Pupil-dilated; 1932 x 1932 pixels; color fundus photograph:
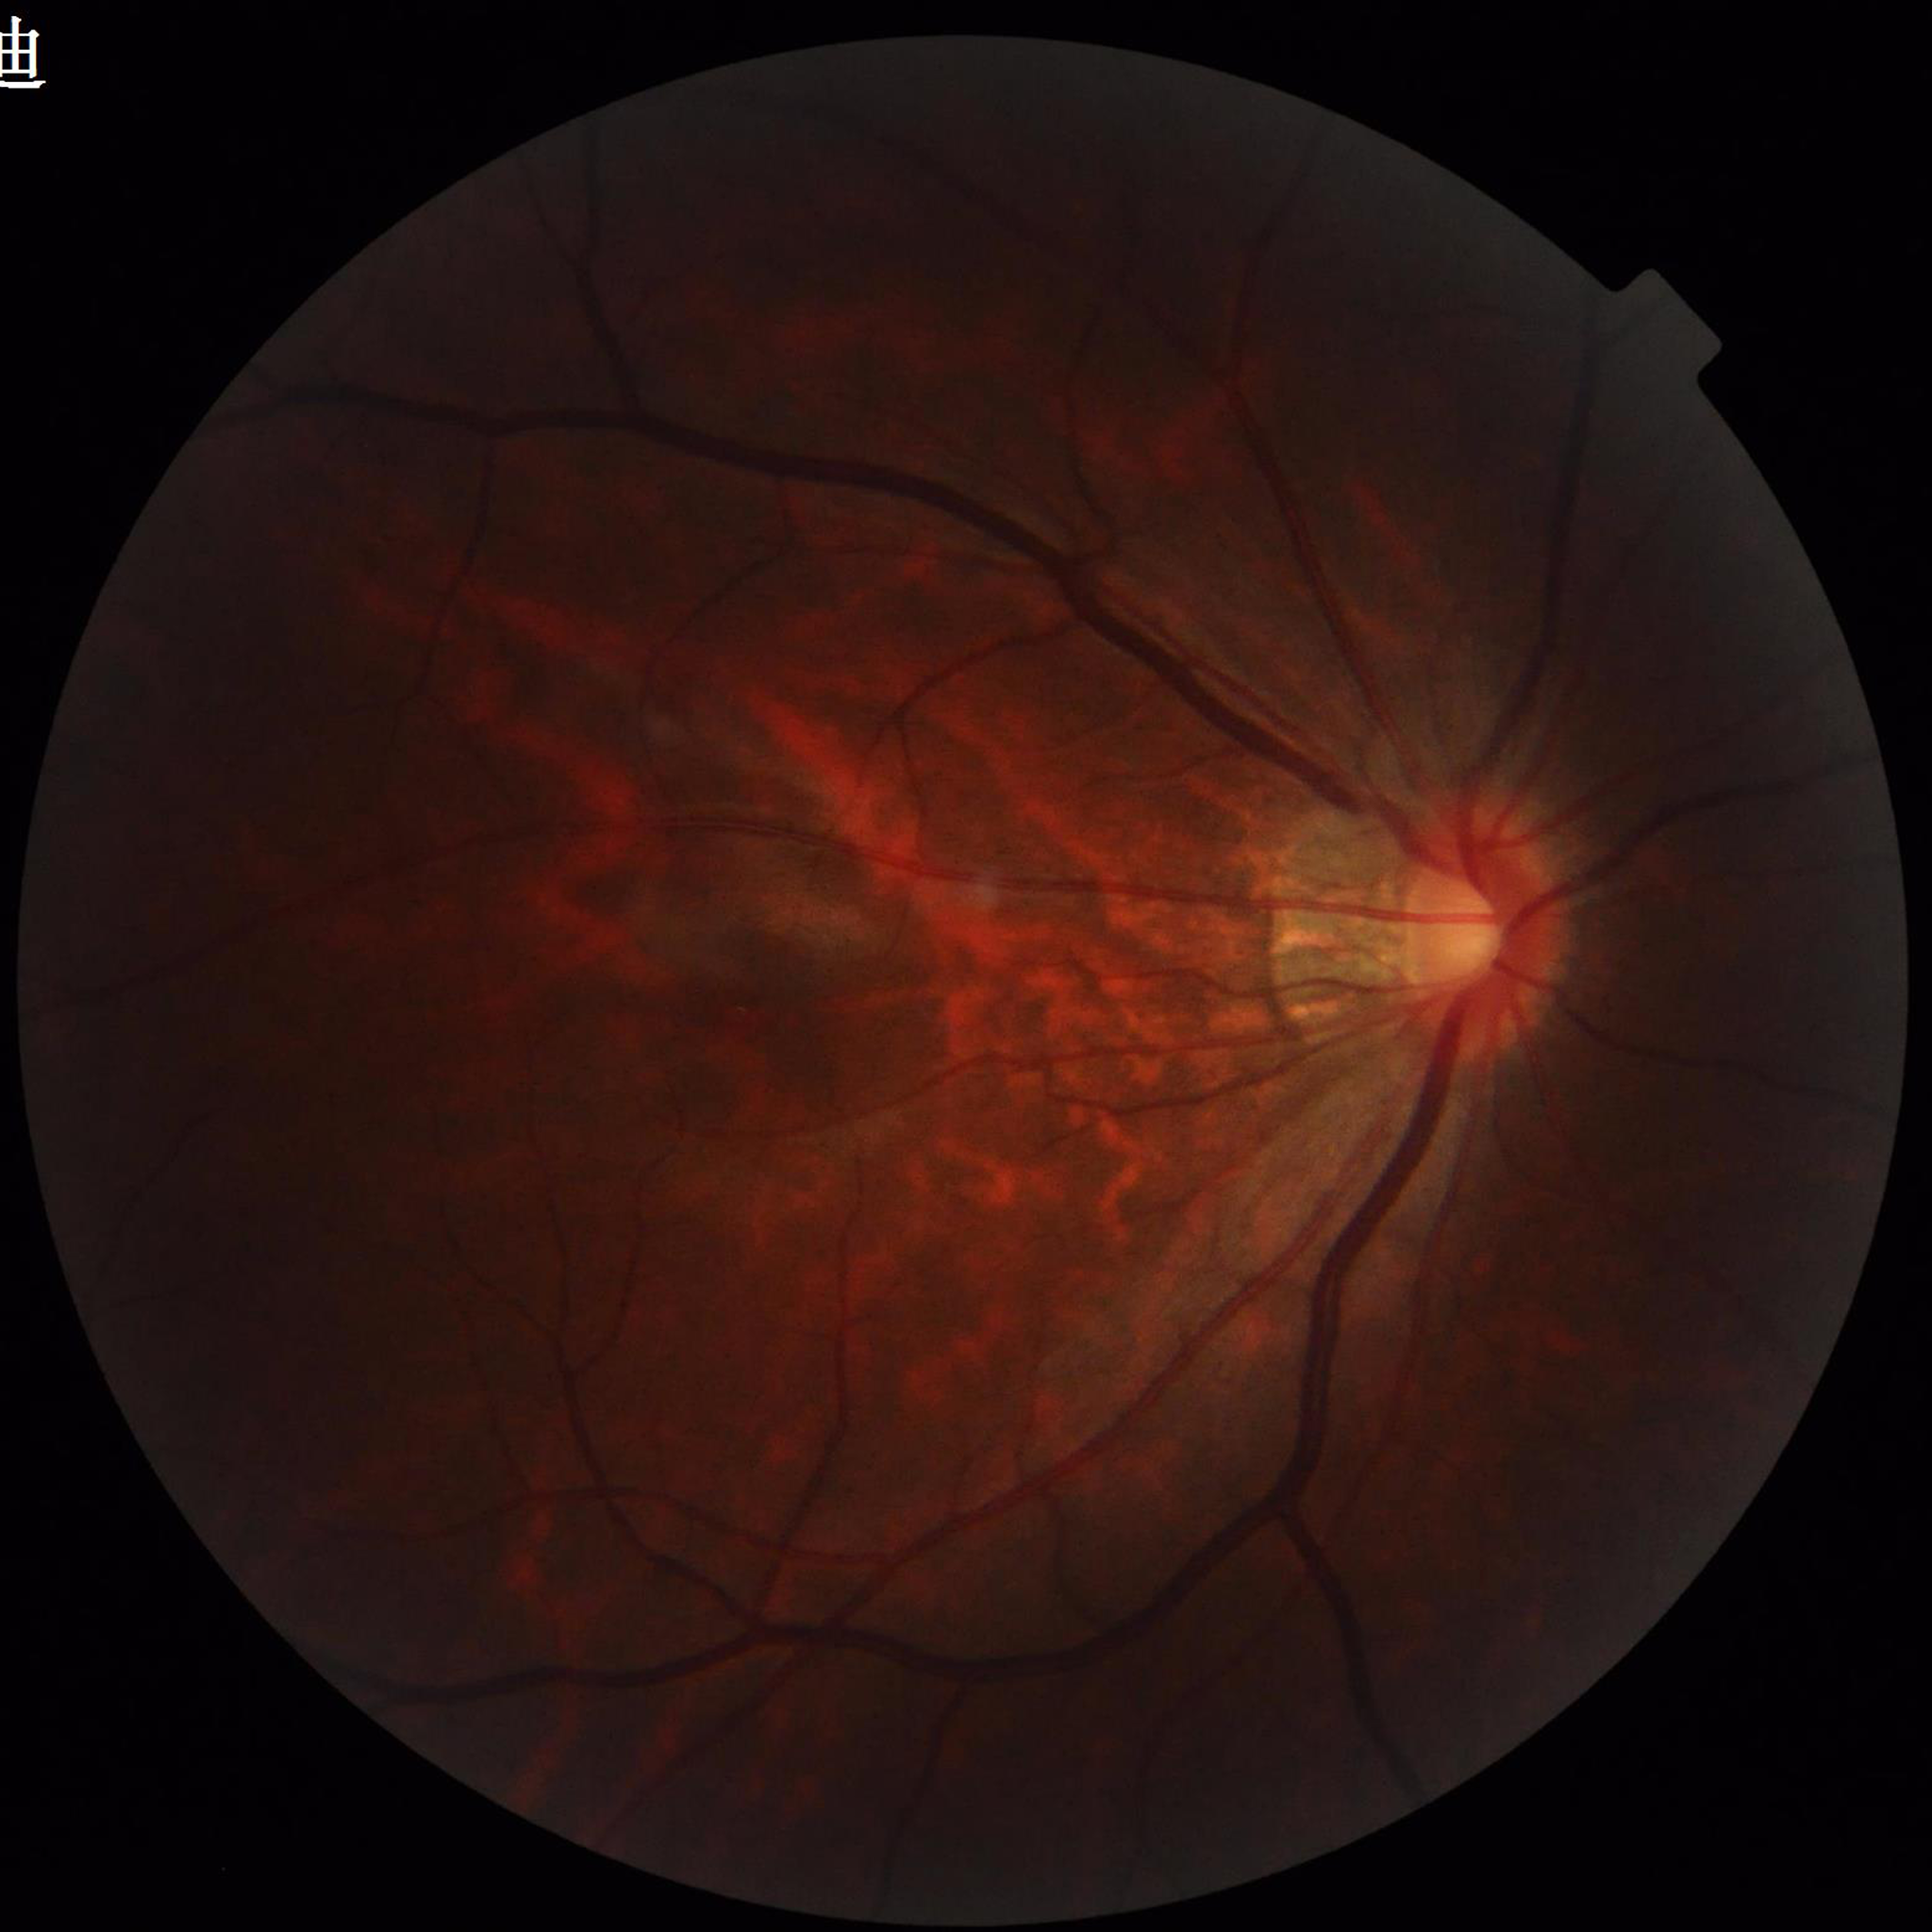 Automated quality assessment: poor — illumination/color distortion.
The patient was diagnosed with diabetic retinopathy.